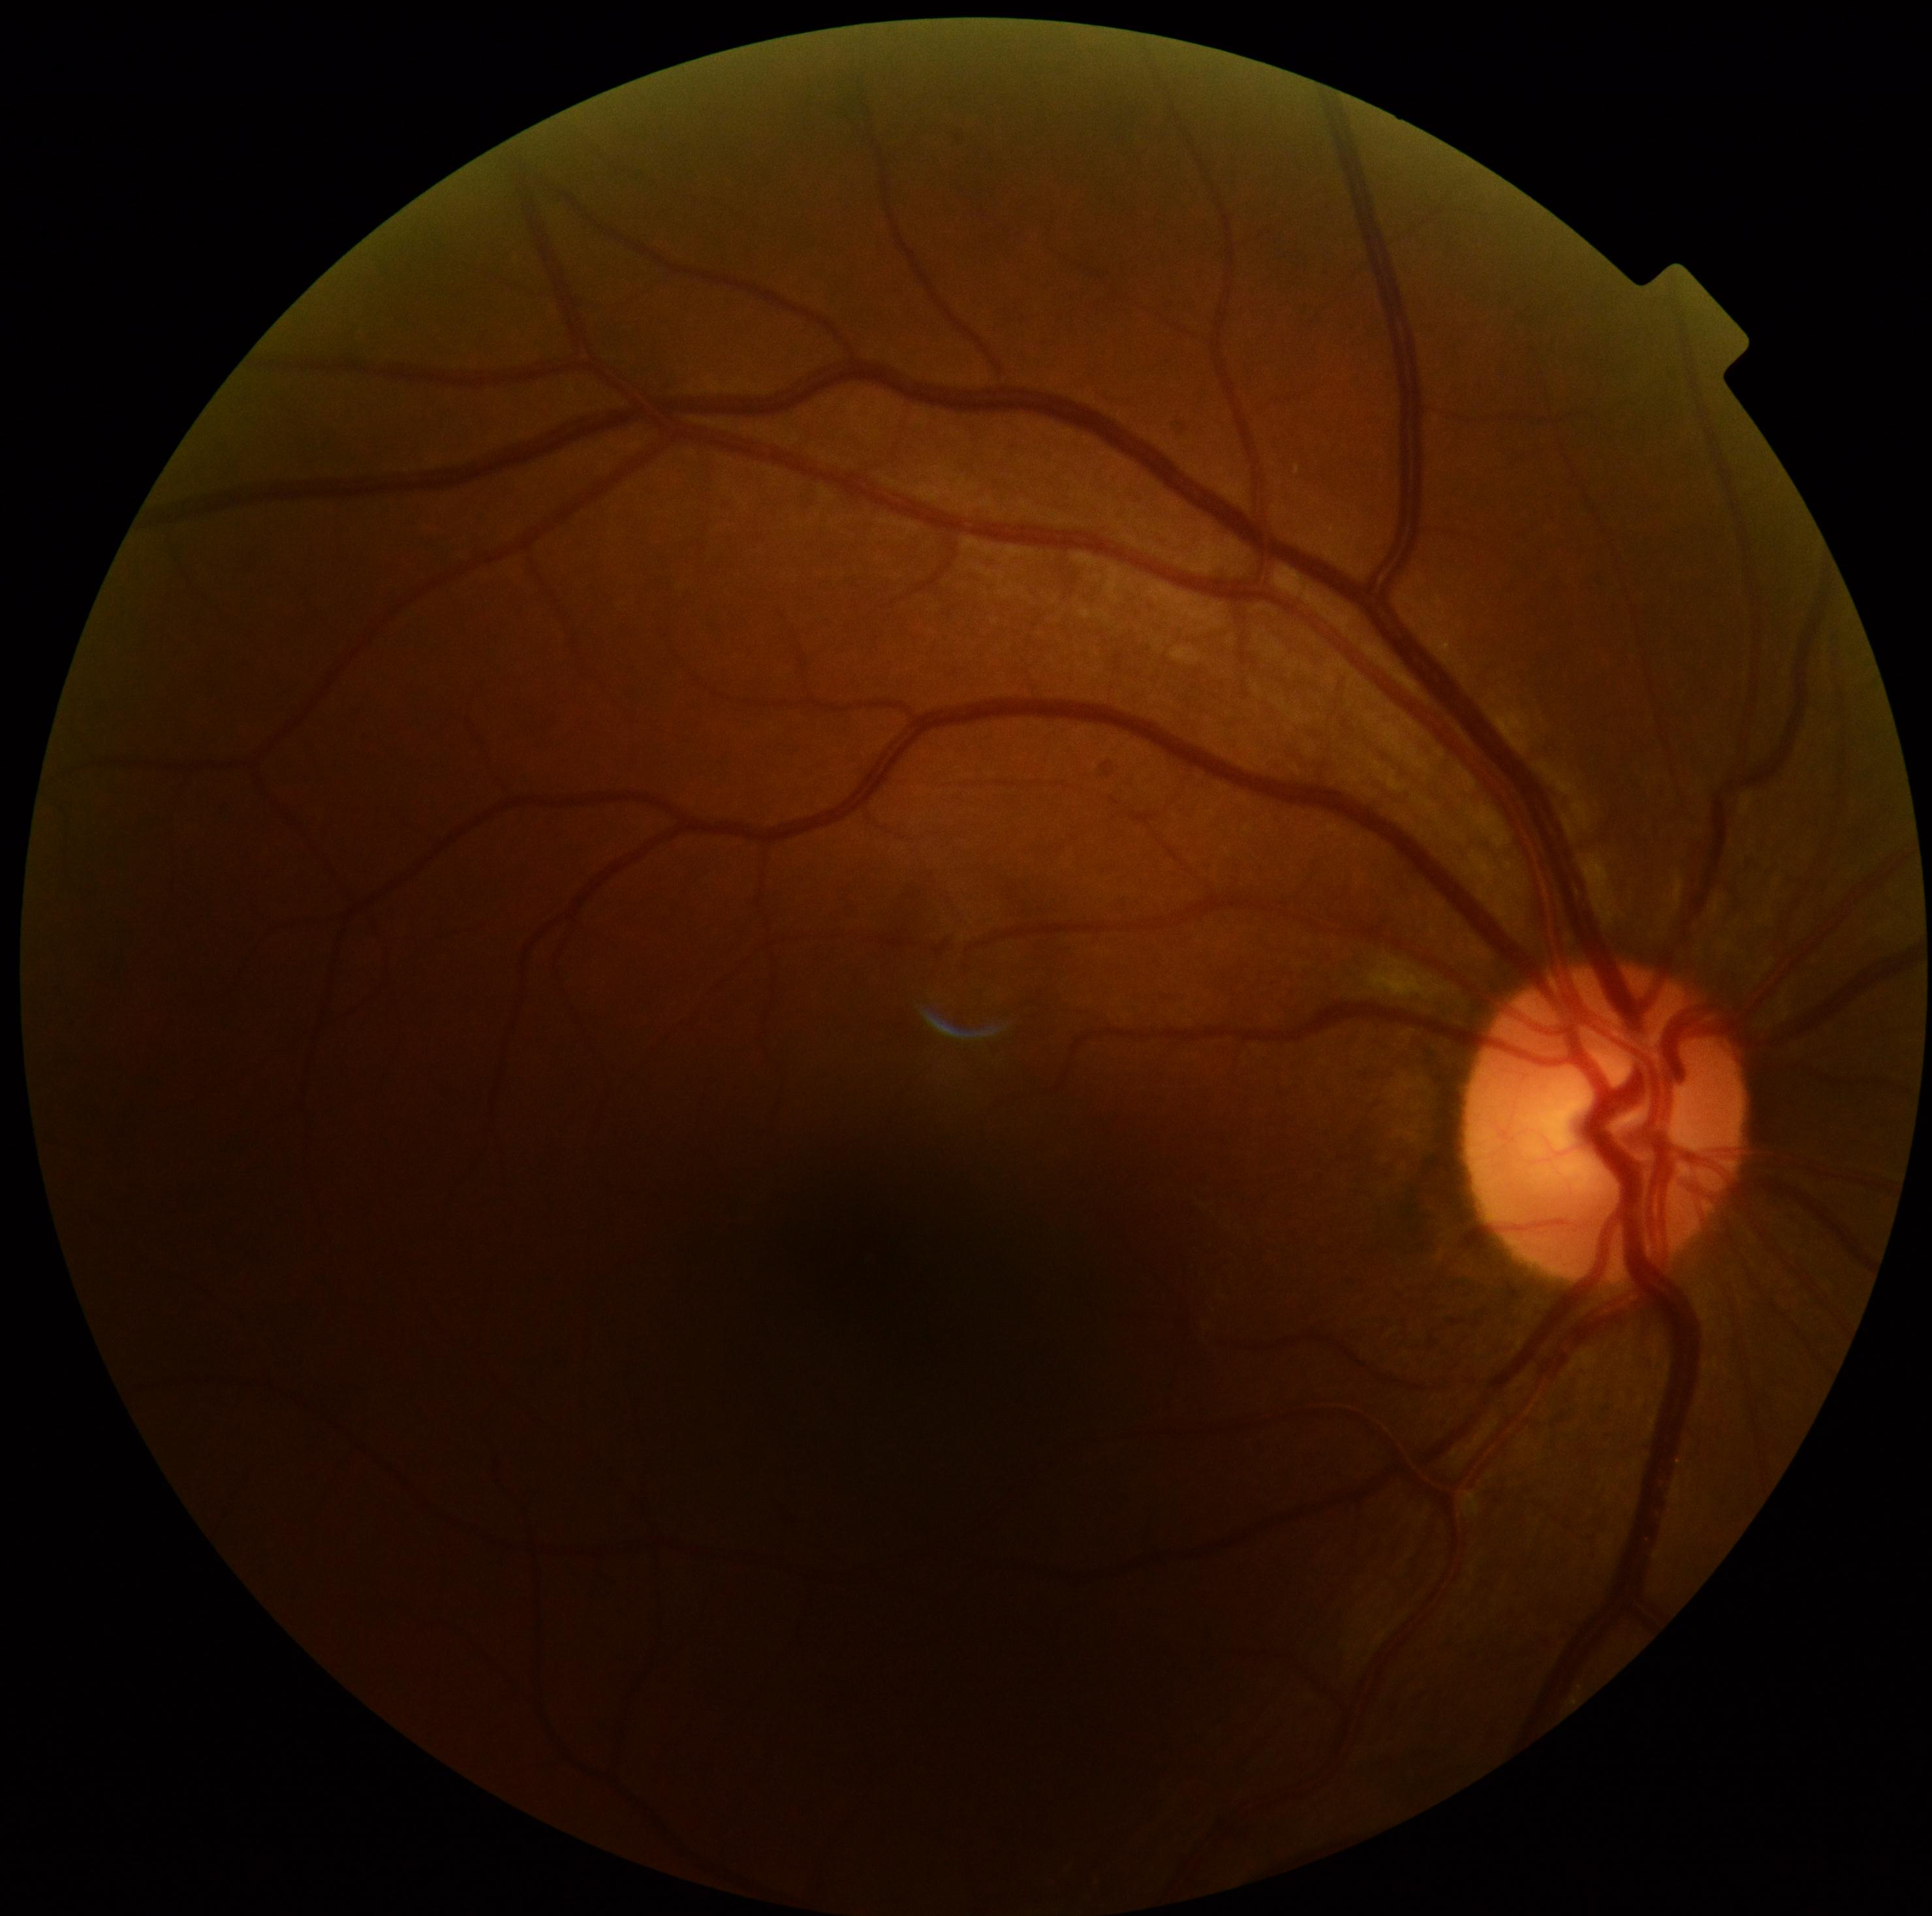
Retinopathy grade: 2. The retinopathy is classified as non-proliferative diabetic retinopathy.